Color fundus image · image size 2184x1690 — 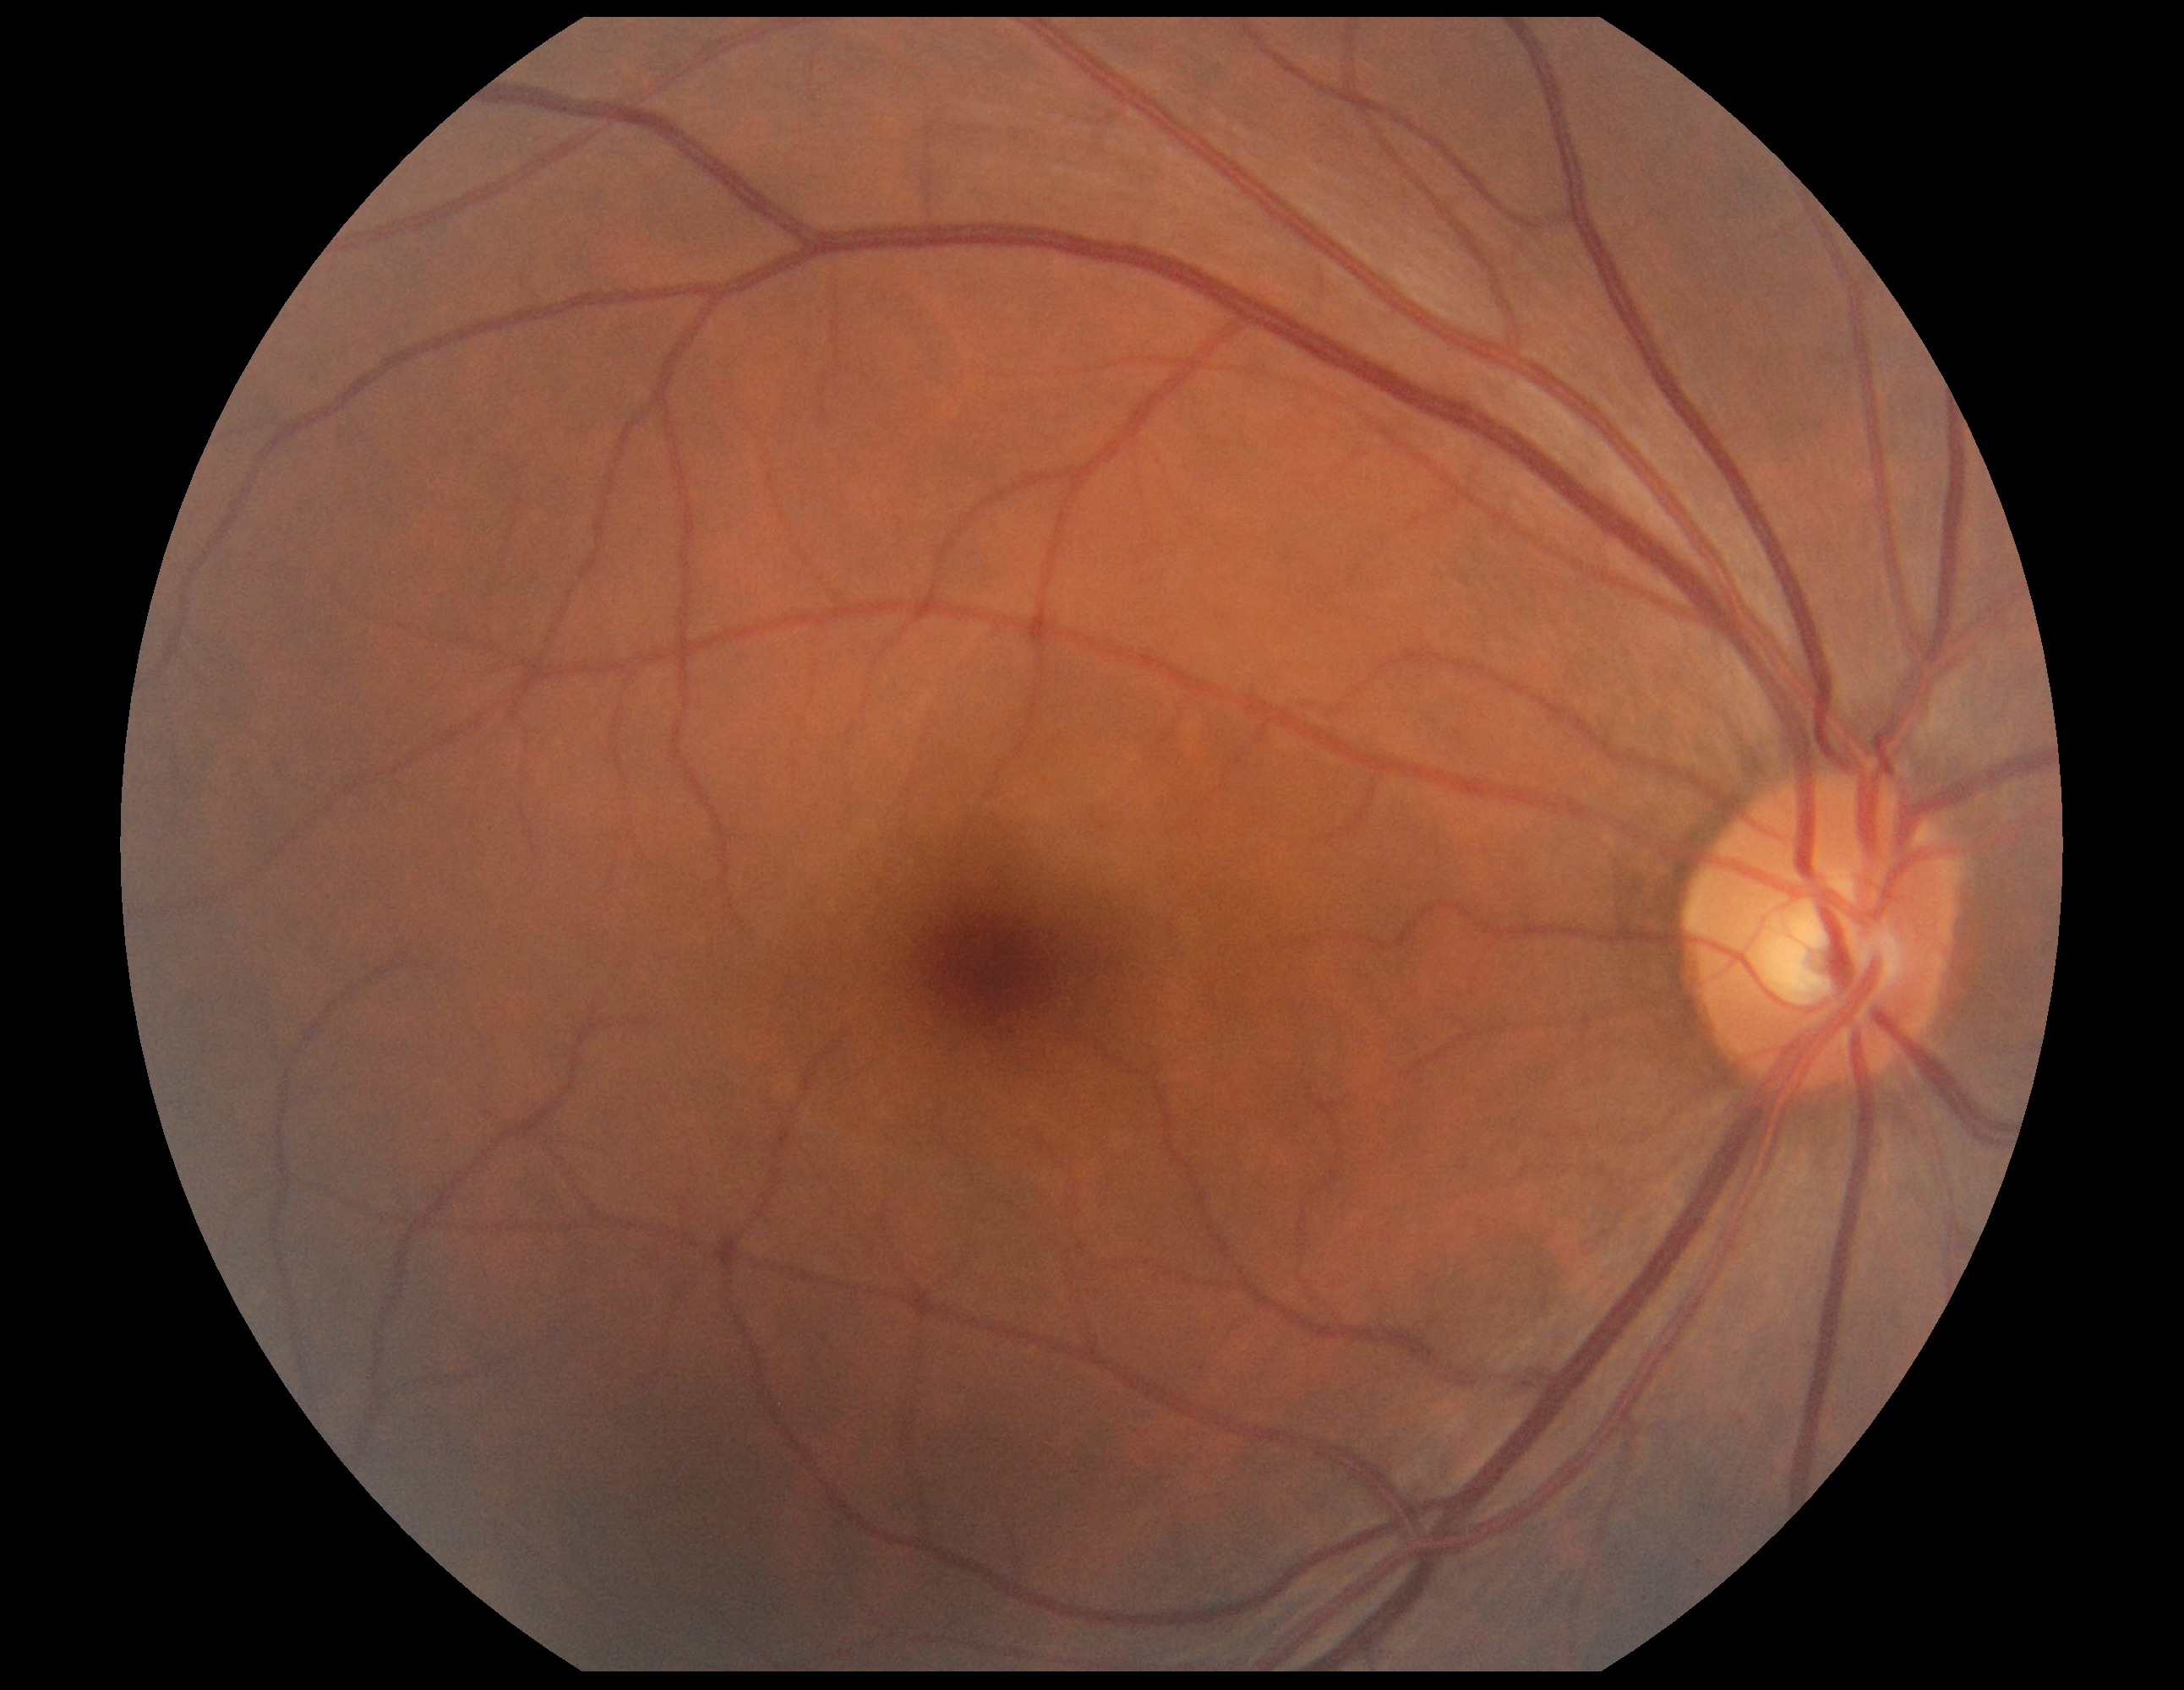 DR: grade 0 (no apparent retinopathy).